2361 x 1568 pixels, color fundus photograph: 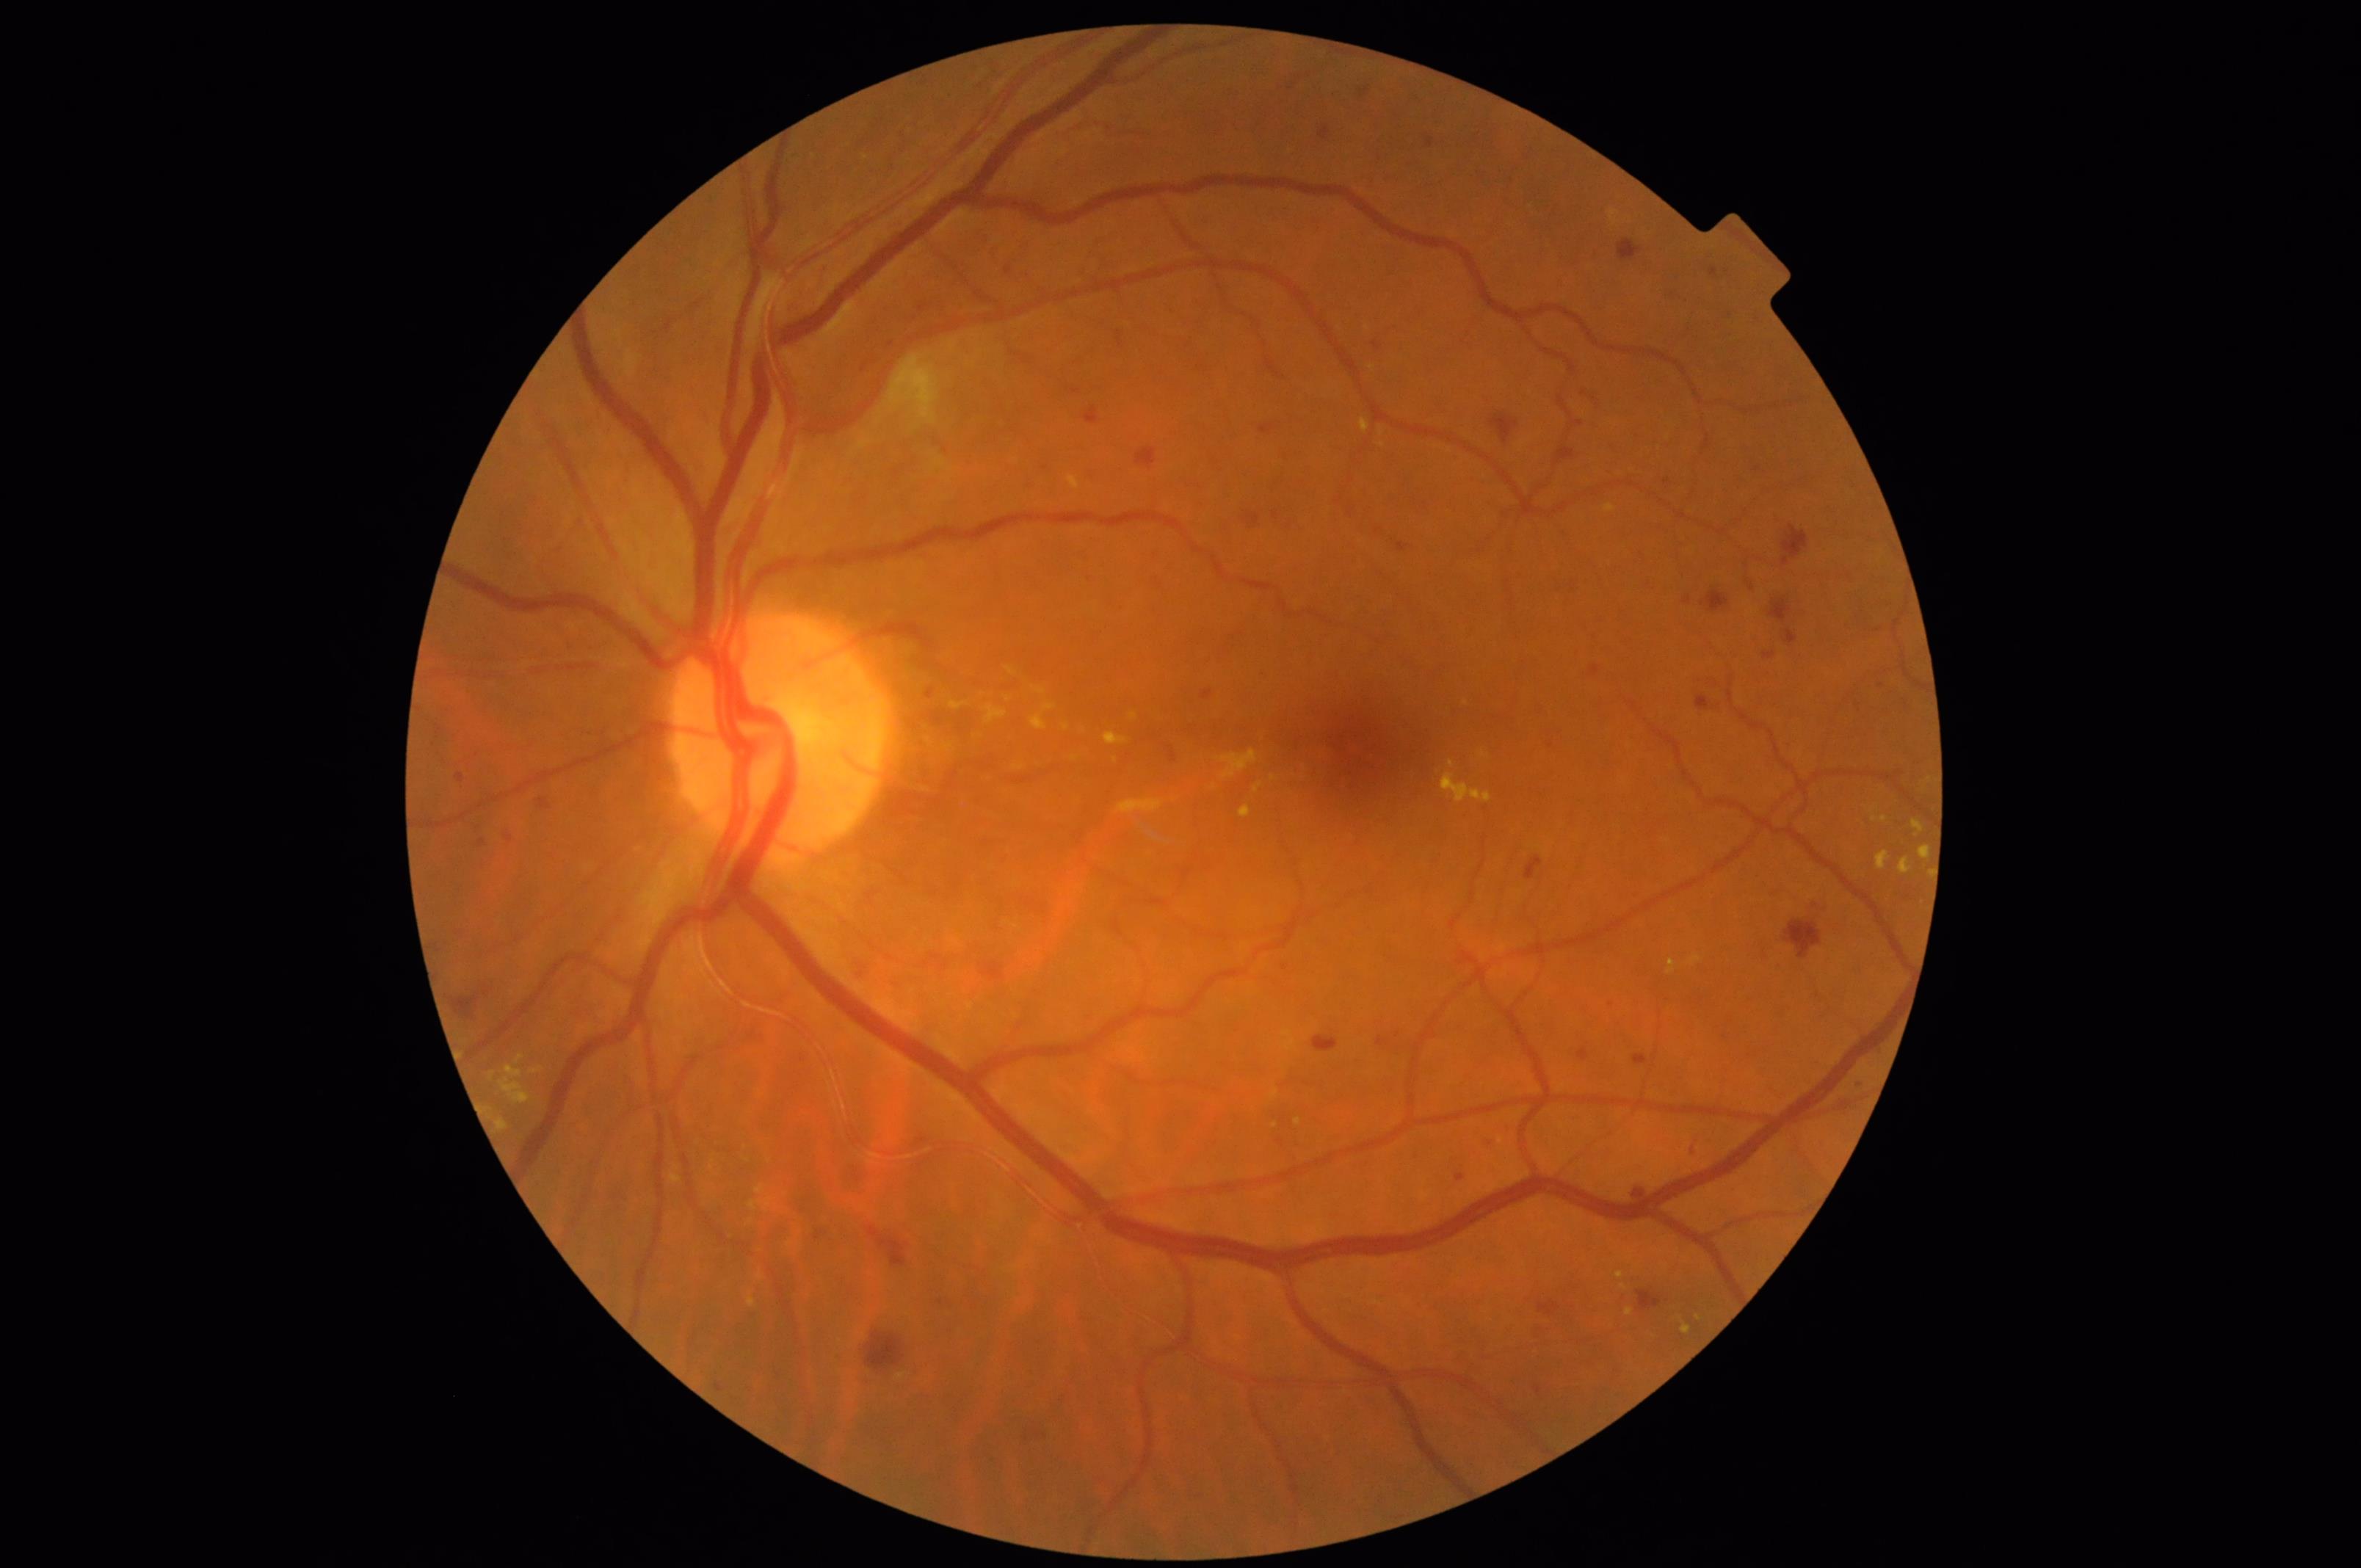
Illumination = good; Clarity = good; Contrast = adequate; Overall image quality = satisfactory.